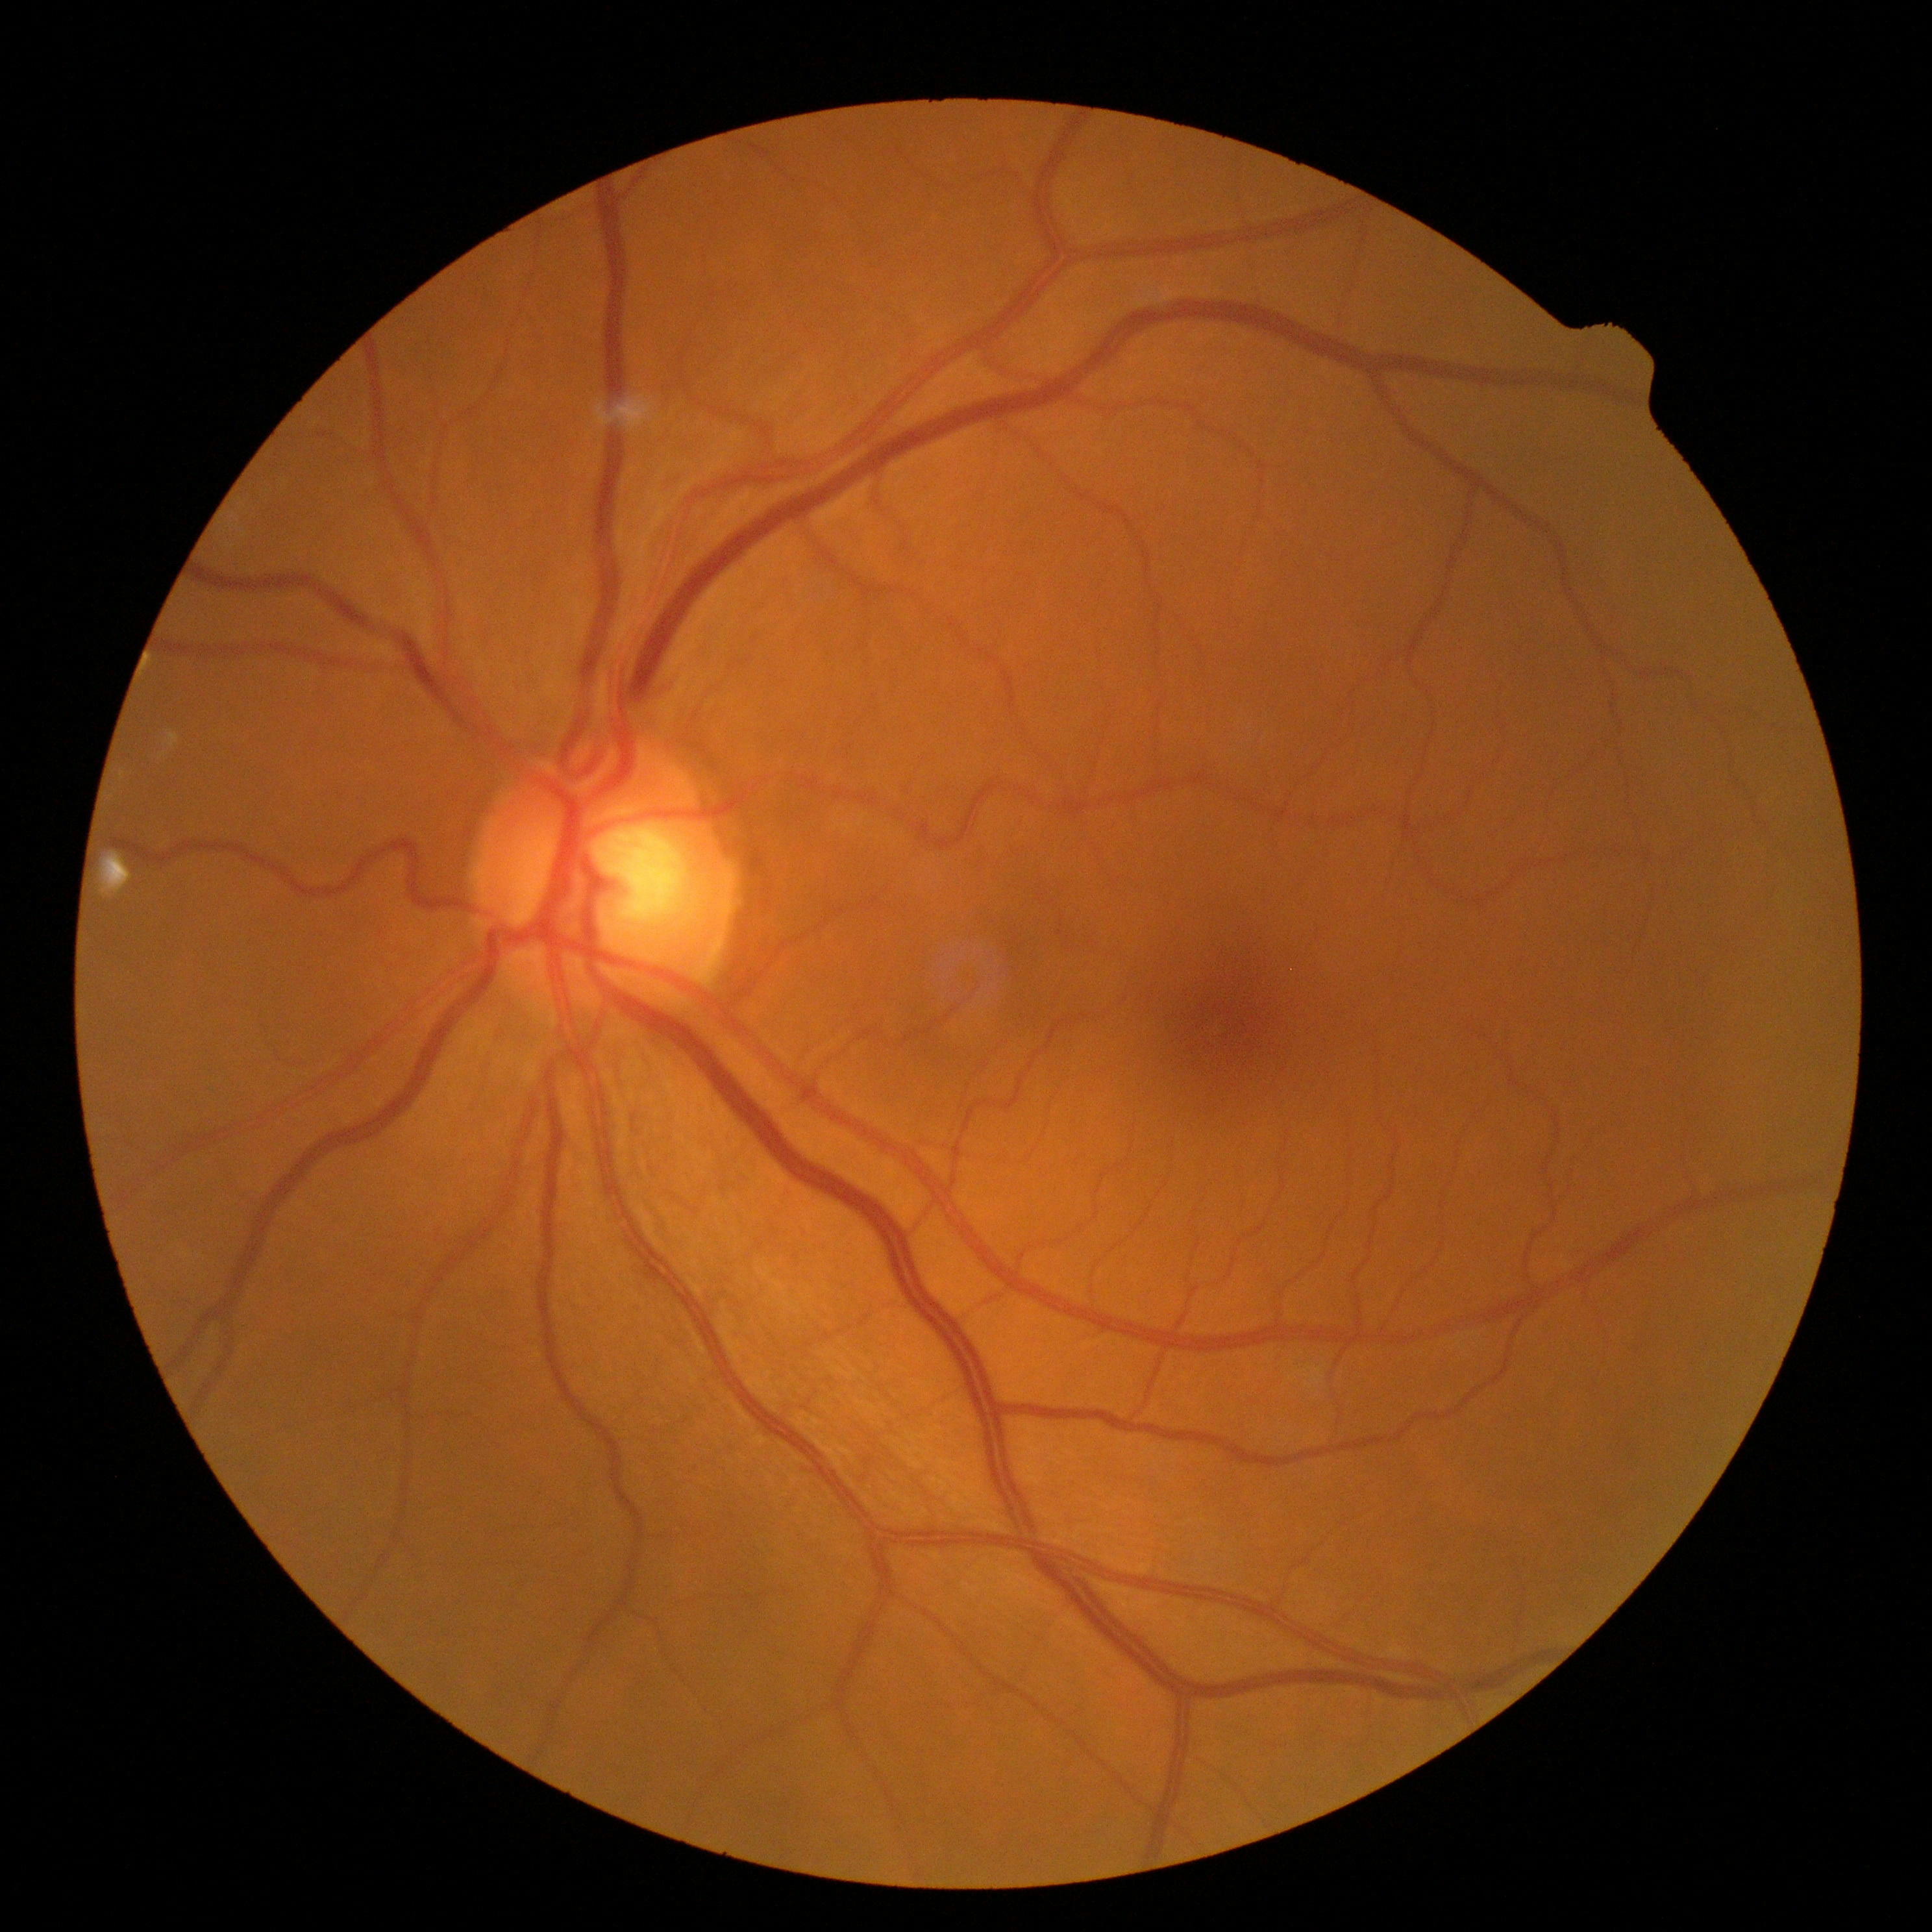 {
  "dr_grade": "no apparent retinopathy (grade 0) — no visible signs of diabetic retinopathy"
}